2352x1568. Color fundus photograph:
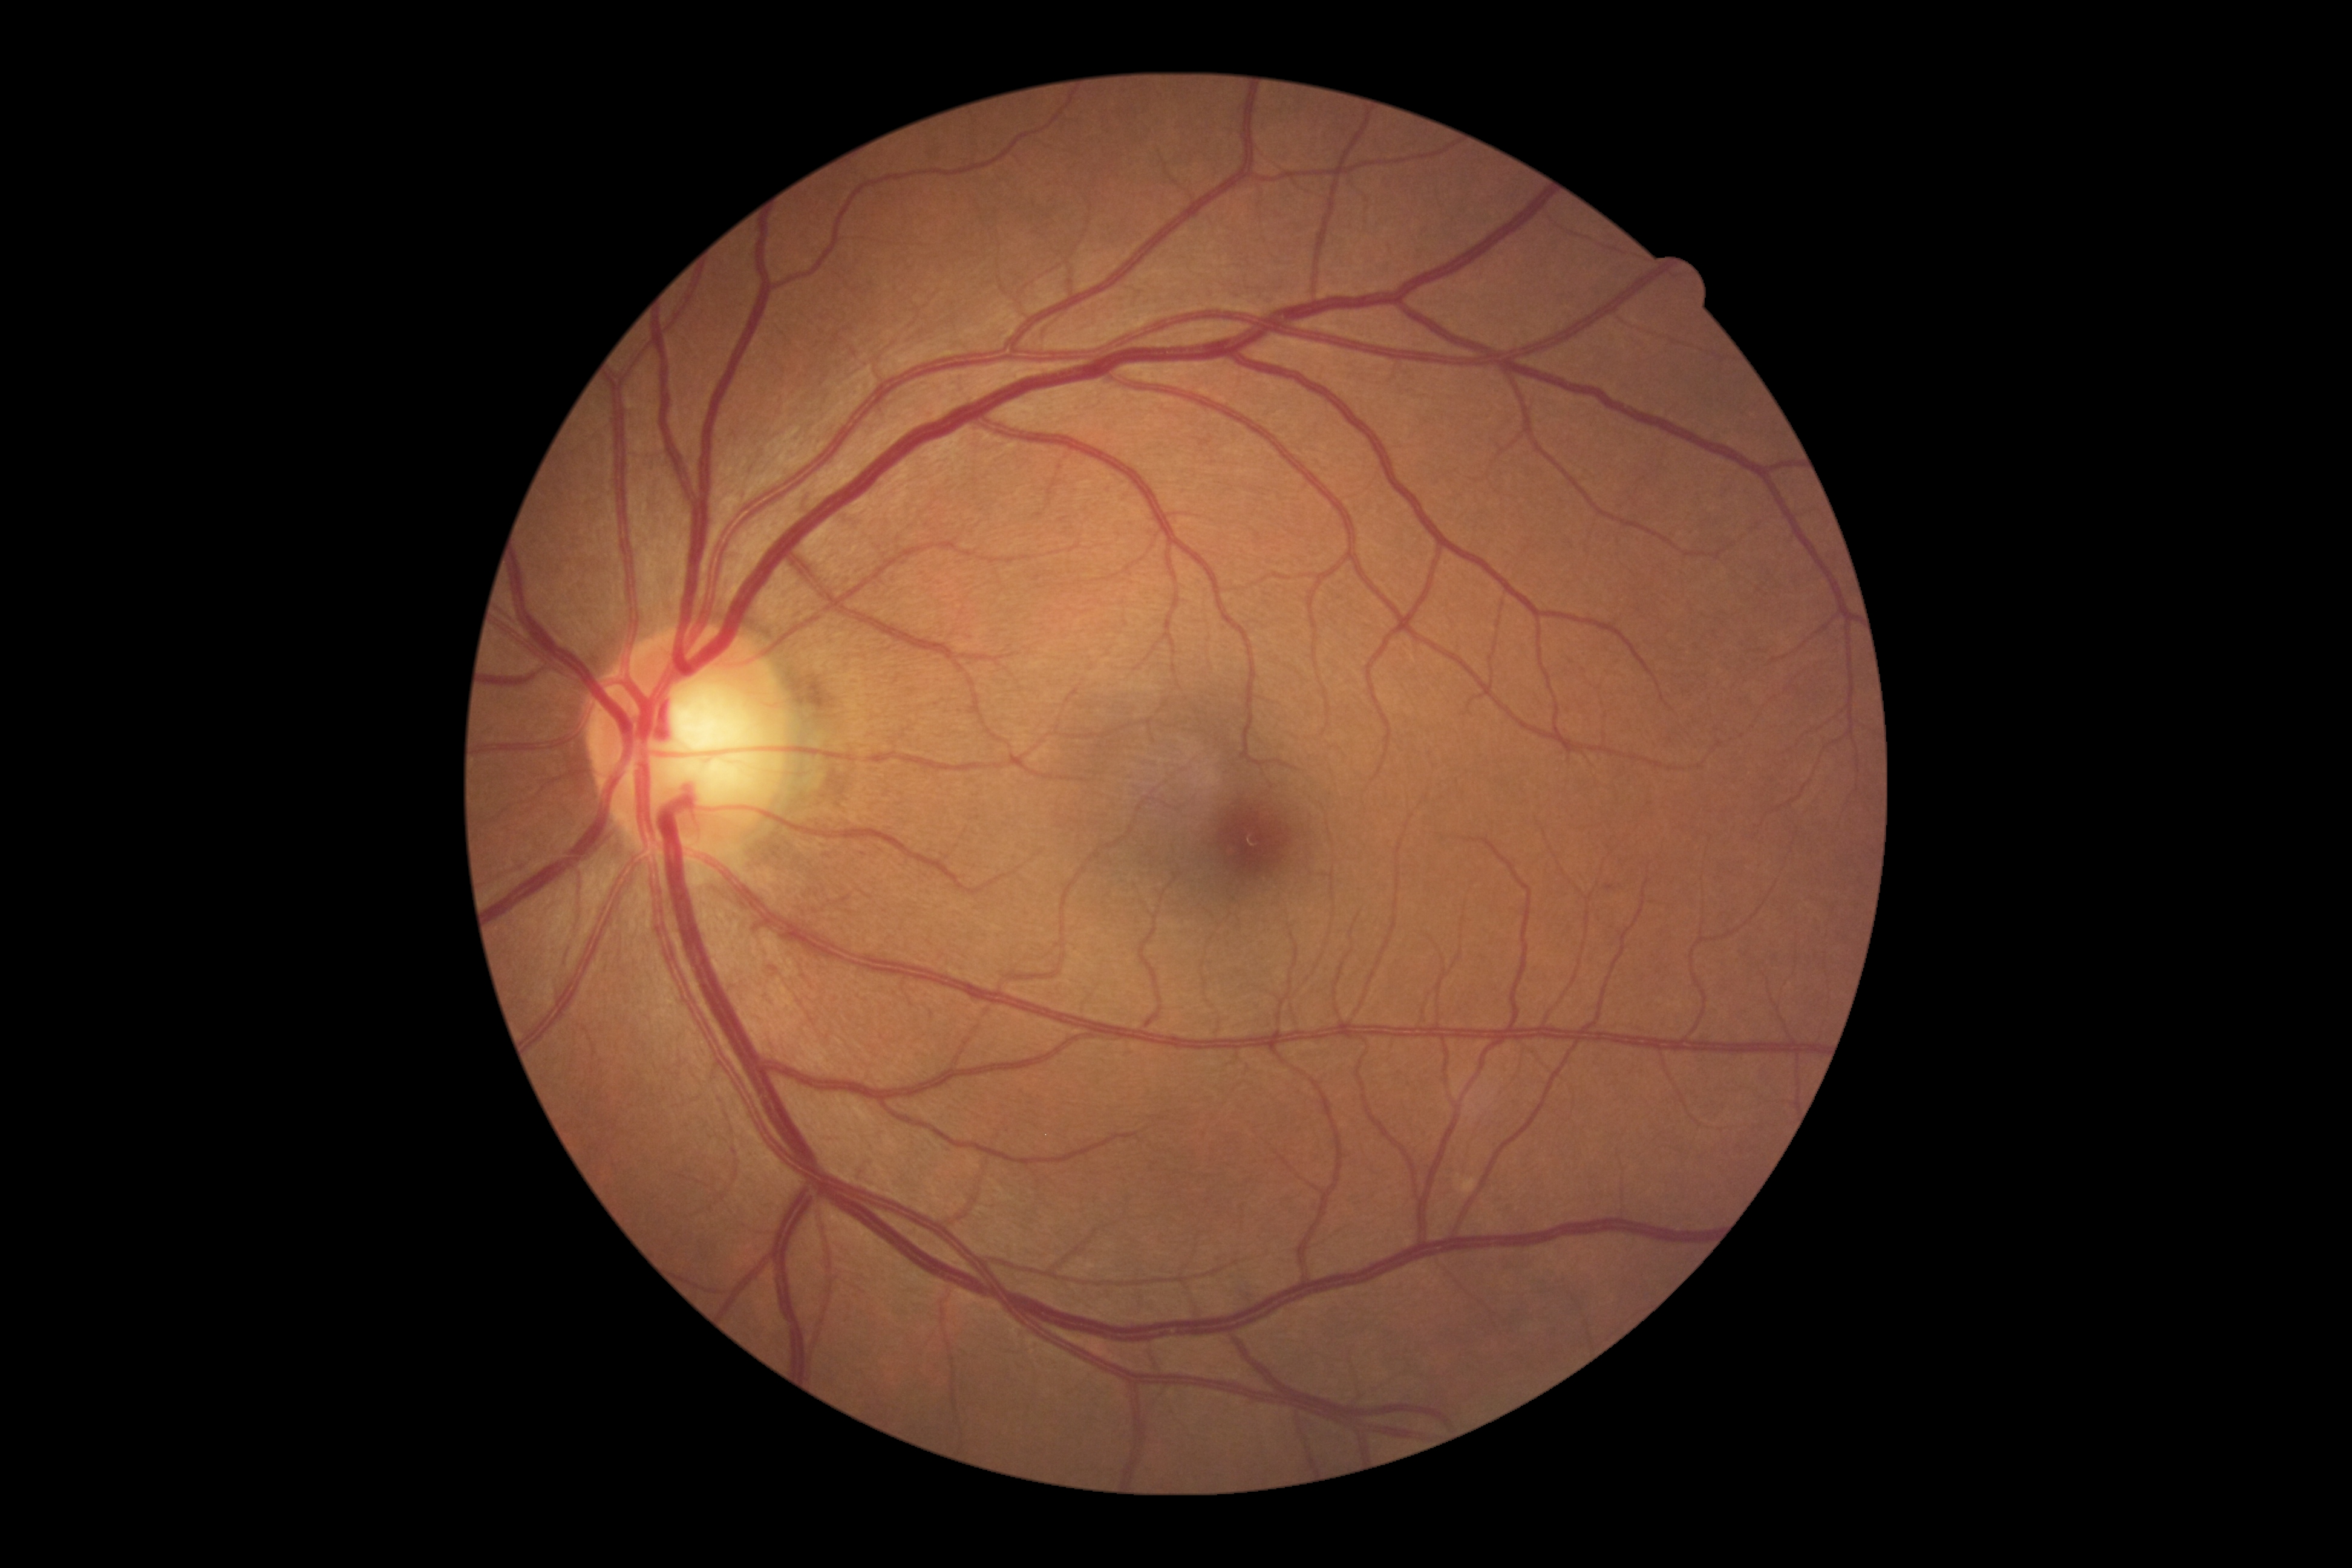

  dr_impression: negative for DR
  dr_grade: grade 0